Wide-field fundus photograph of an infant. Camera: Phoenix ICON (100° FOV): 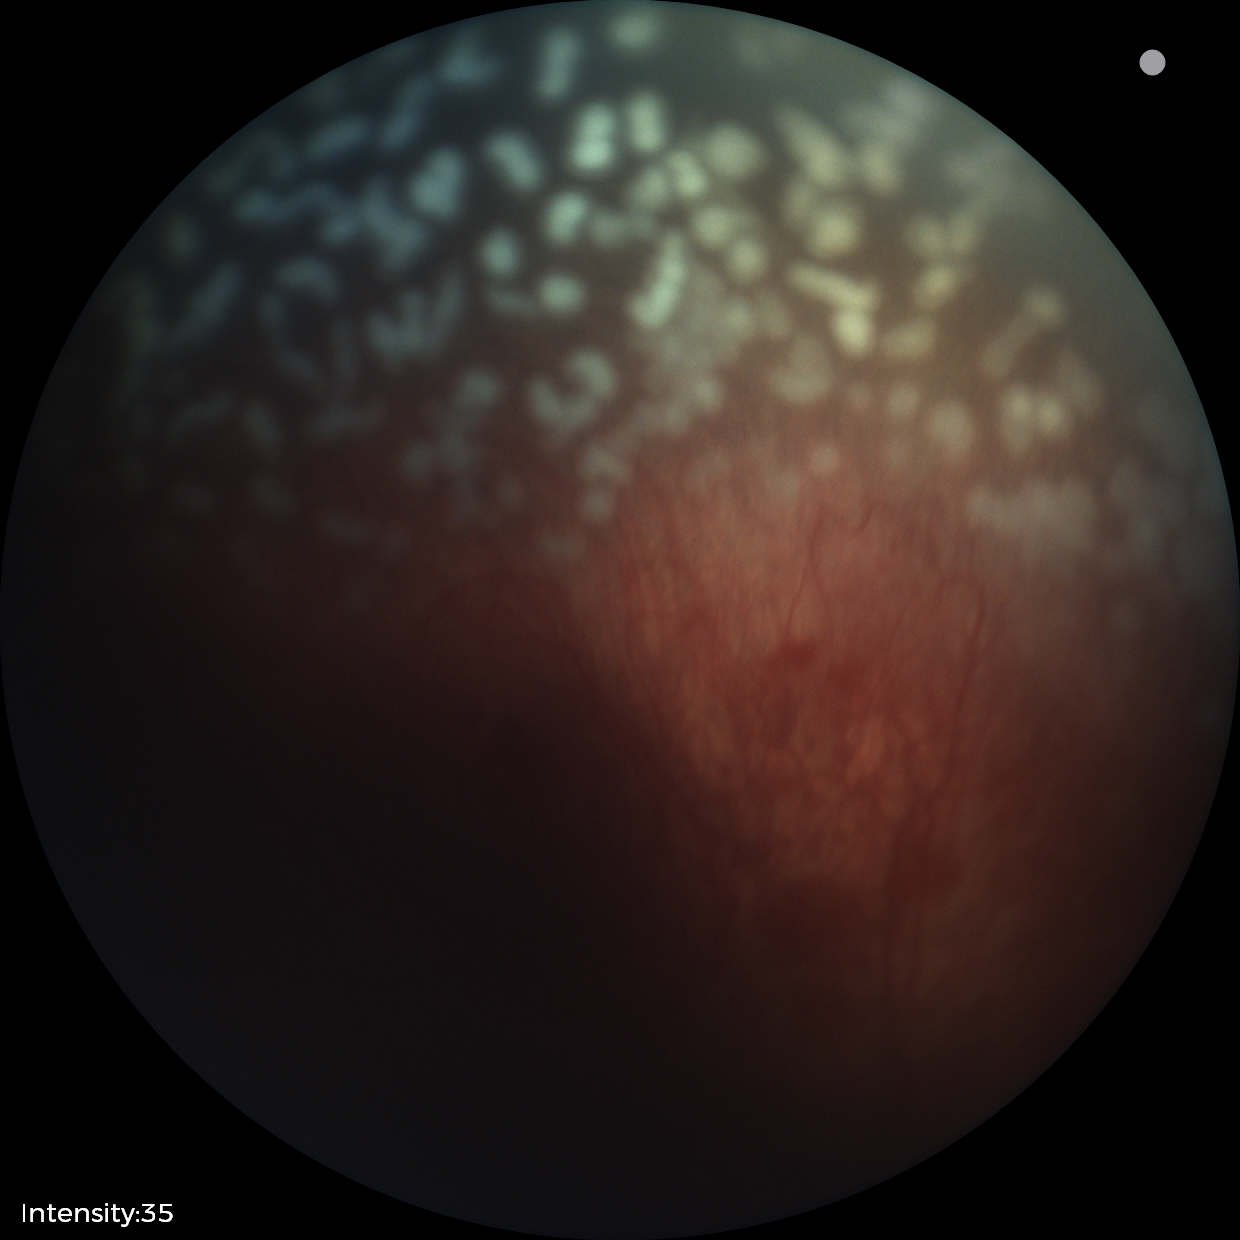

With plus disease. From an examination with diagnosis of retinopathy of prematurity stage 2.